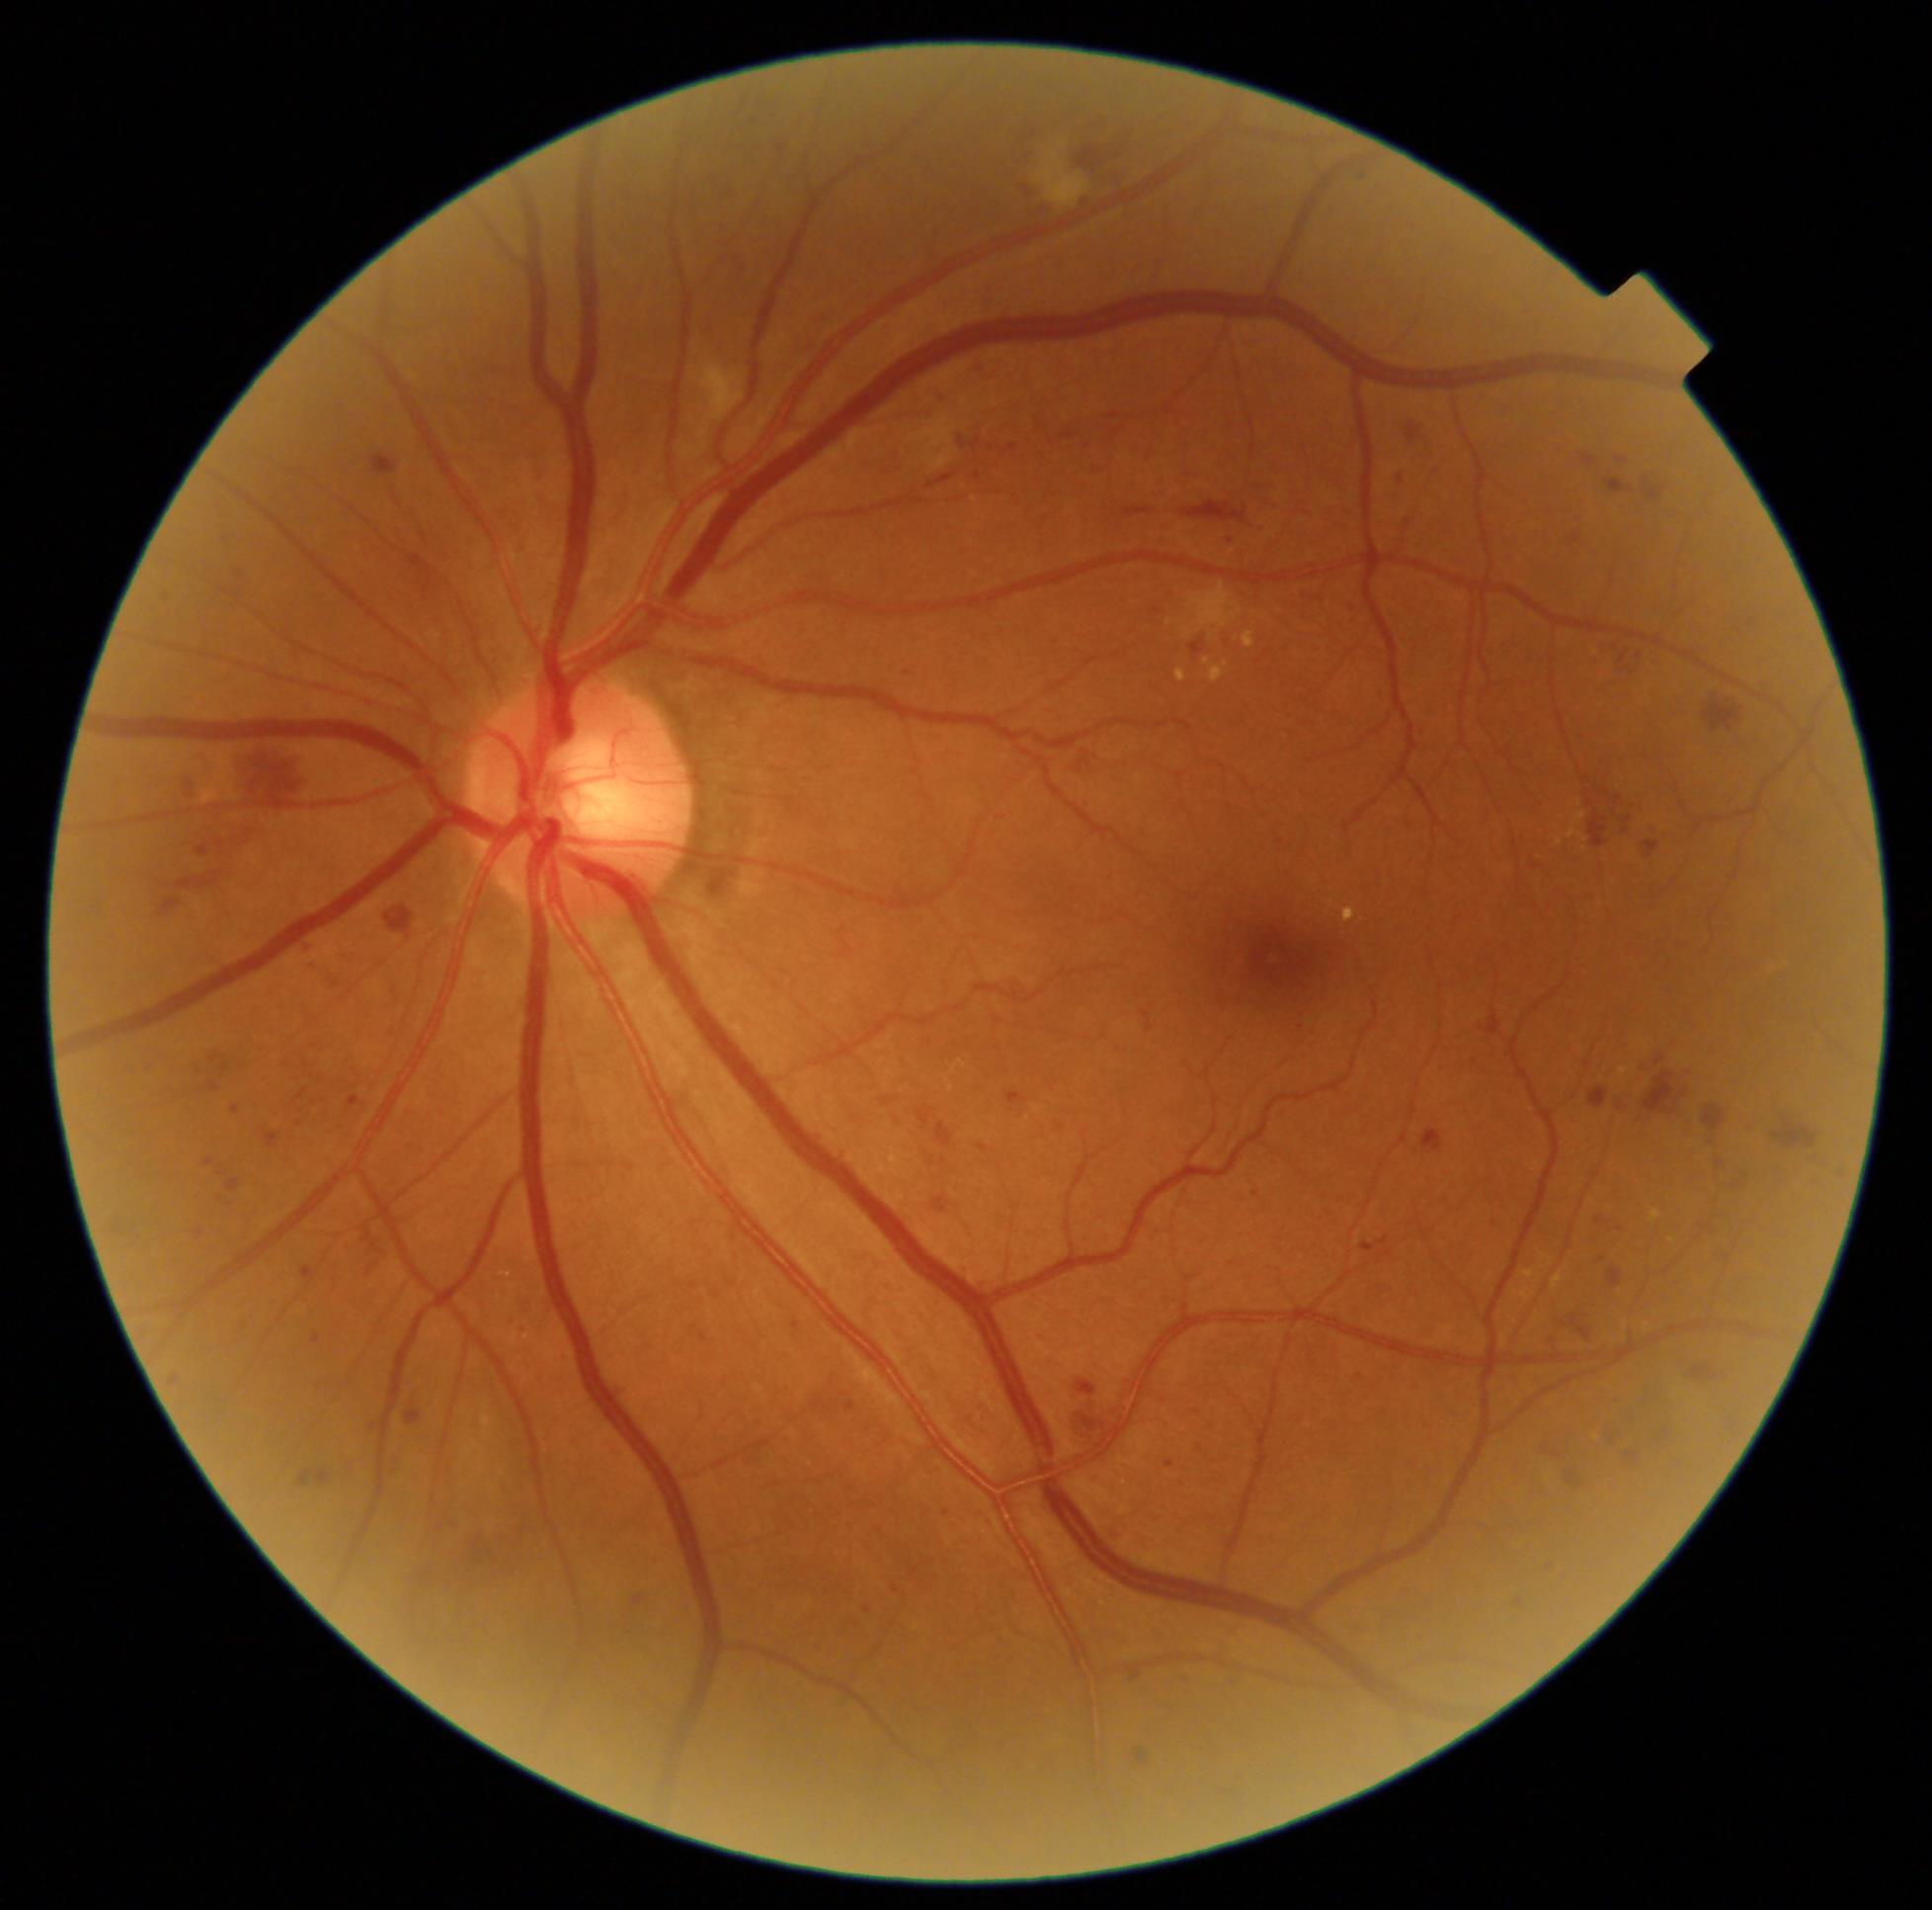 DR severity@grade 3 (severe NPDR).